Color fundus image — 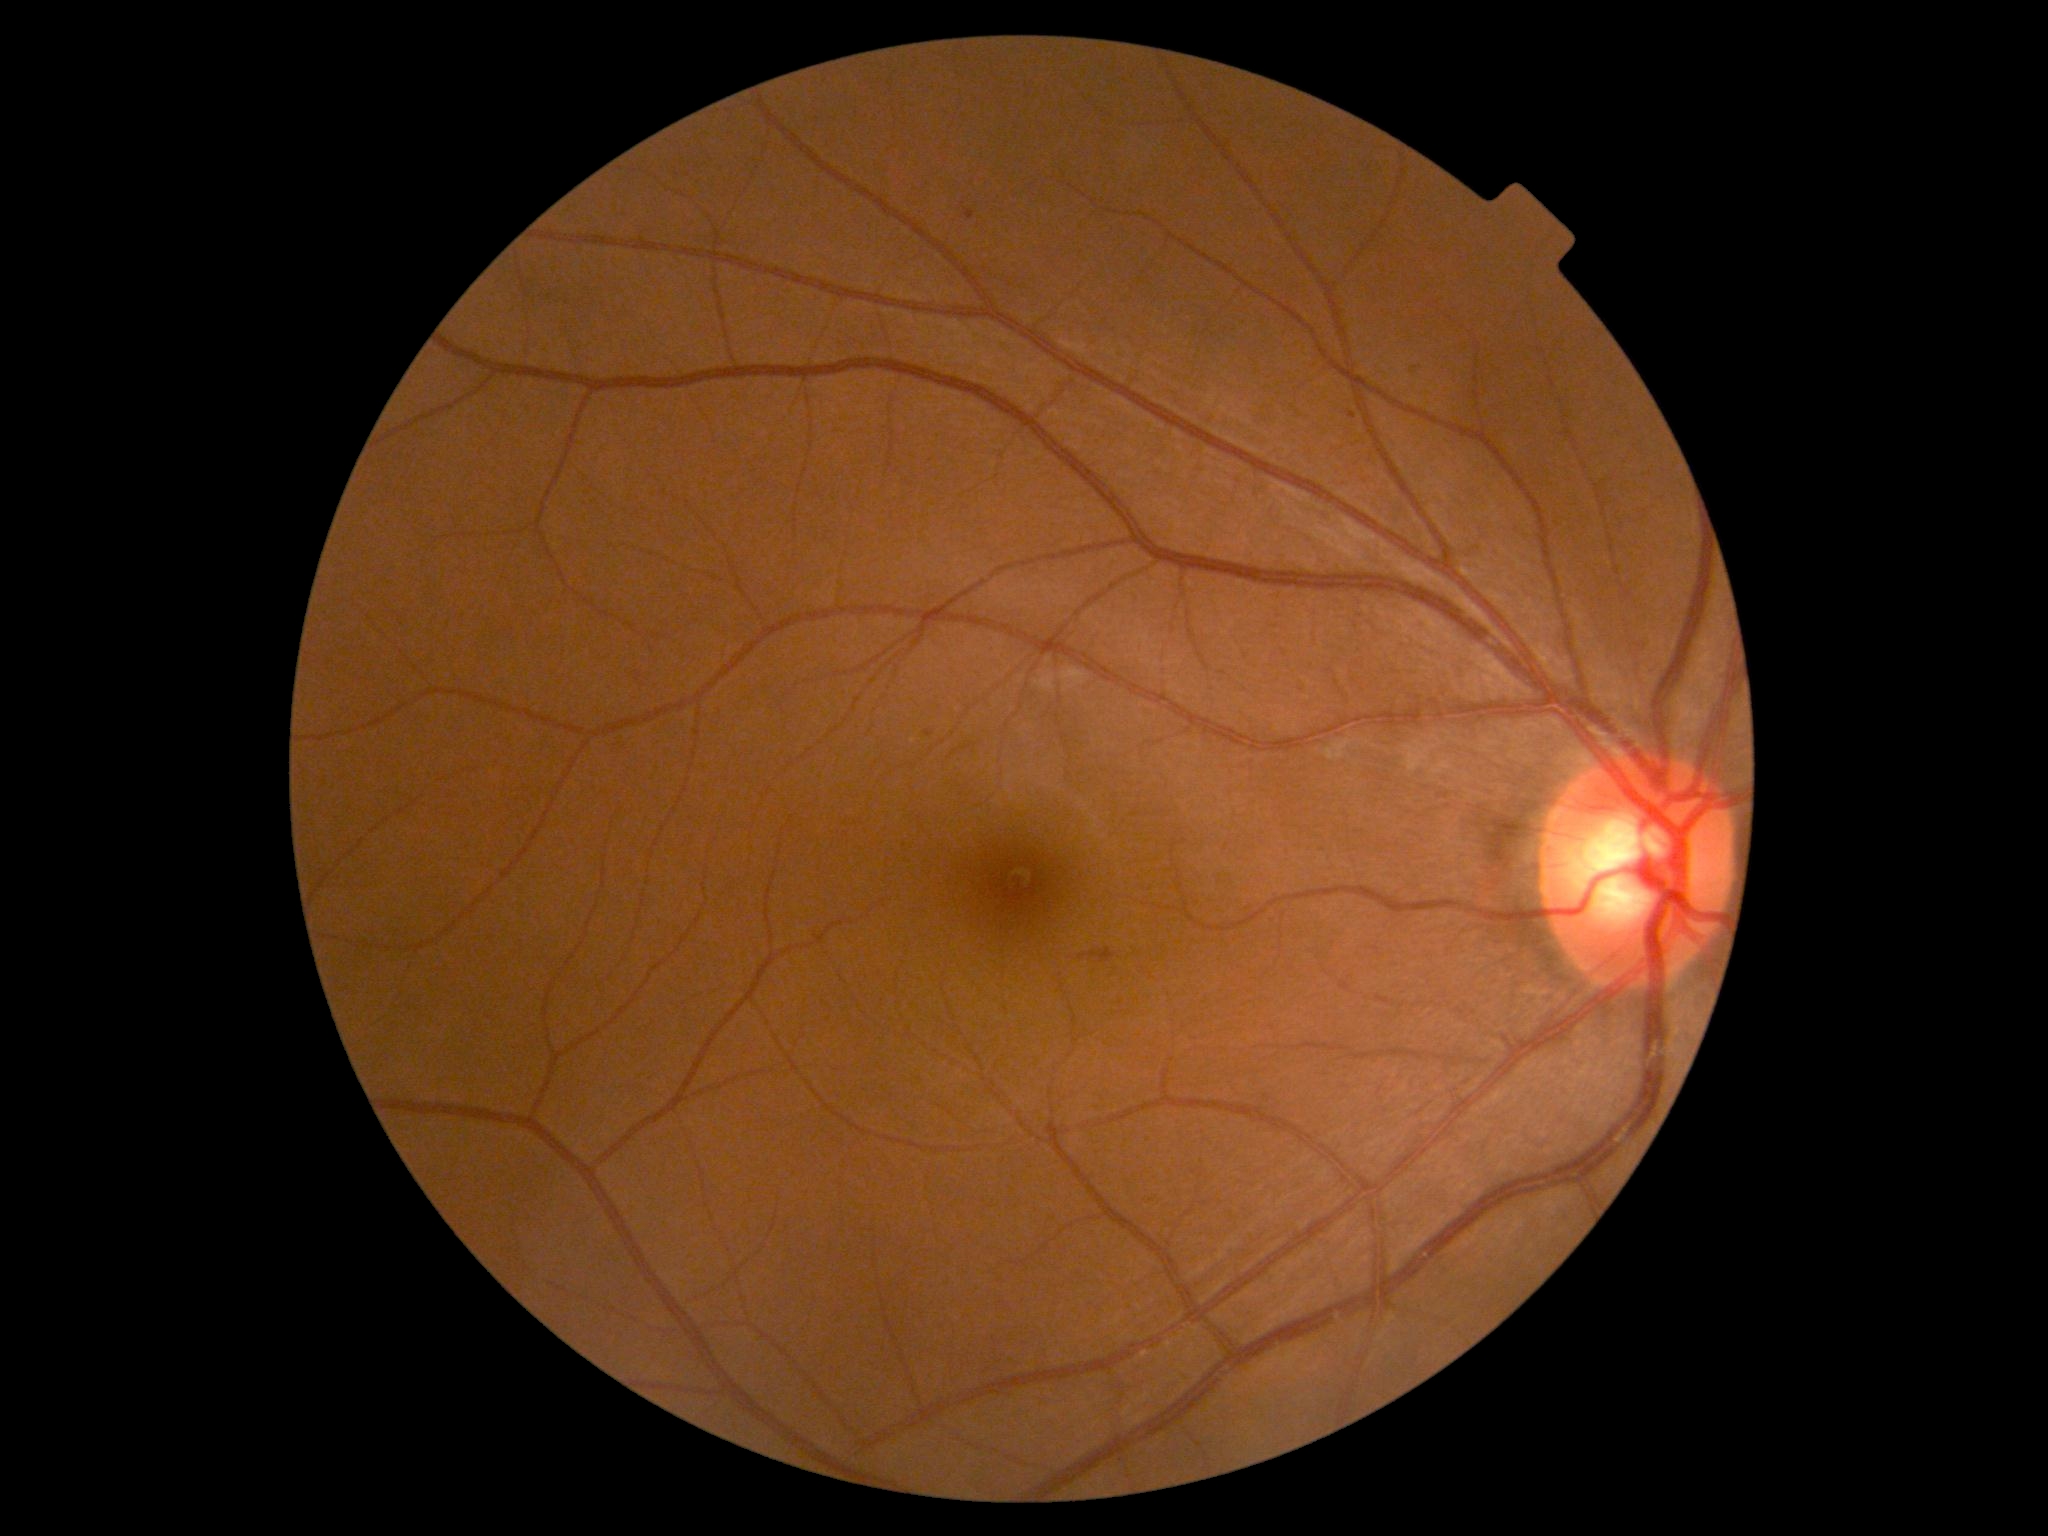
Diabetic retinopathy severity: 2/4.